Captured on a Remidio Fundus on Phone:
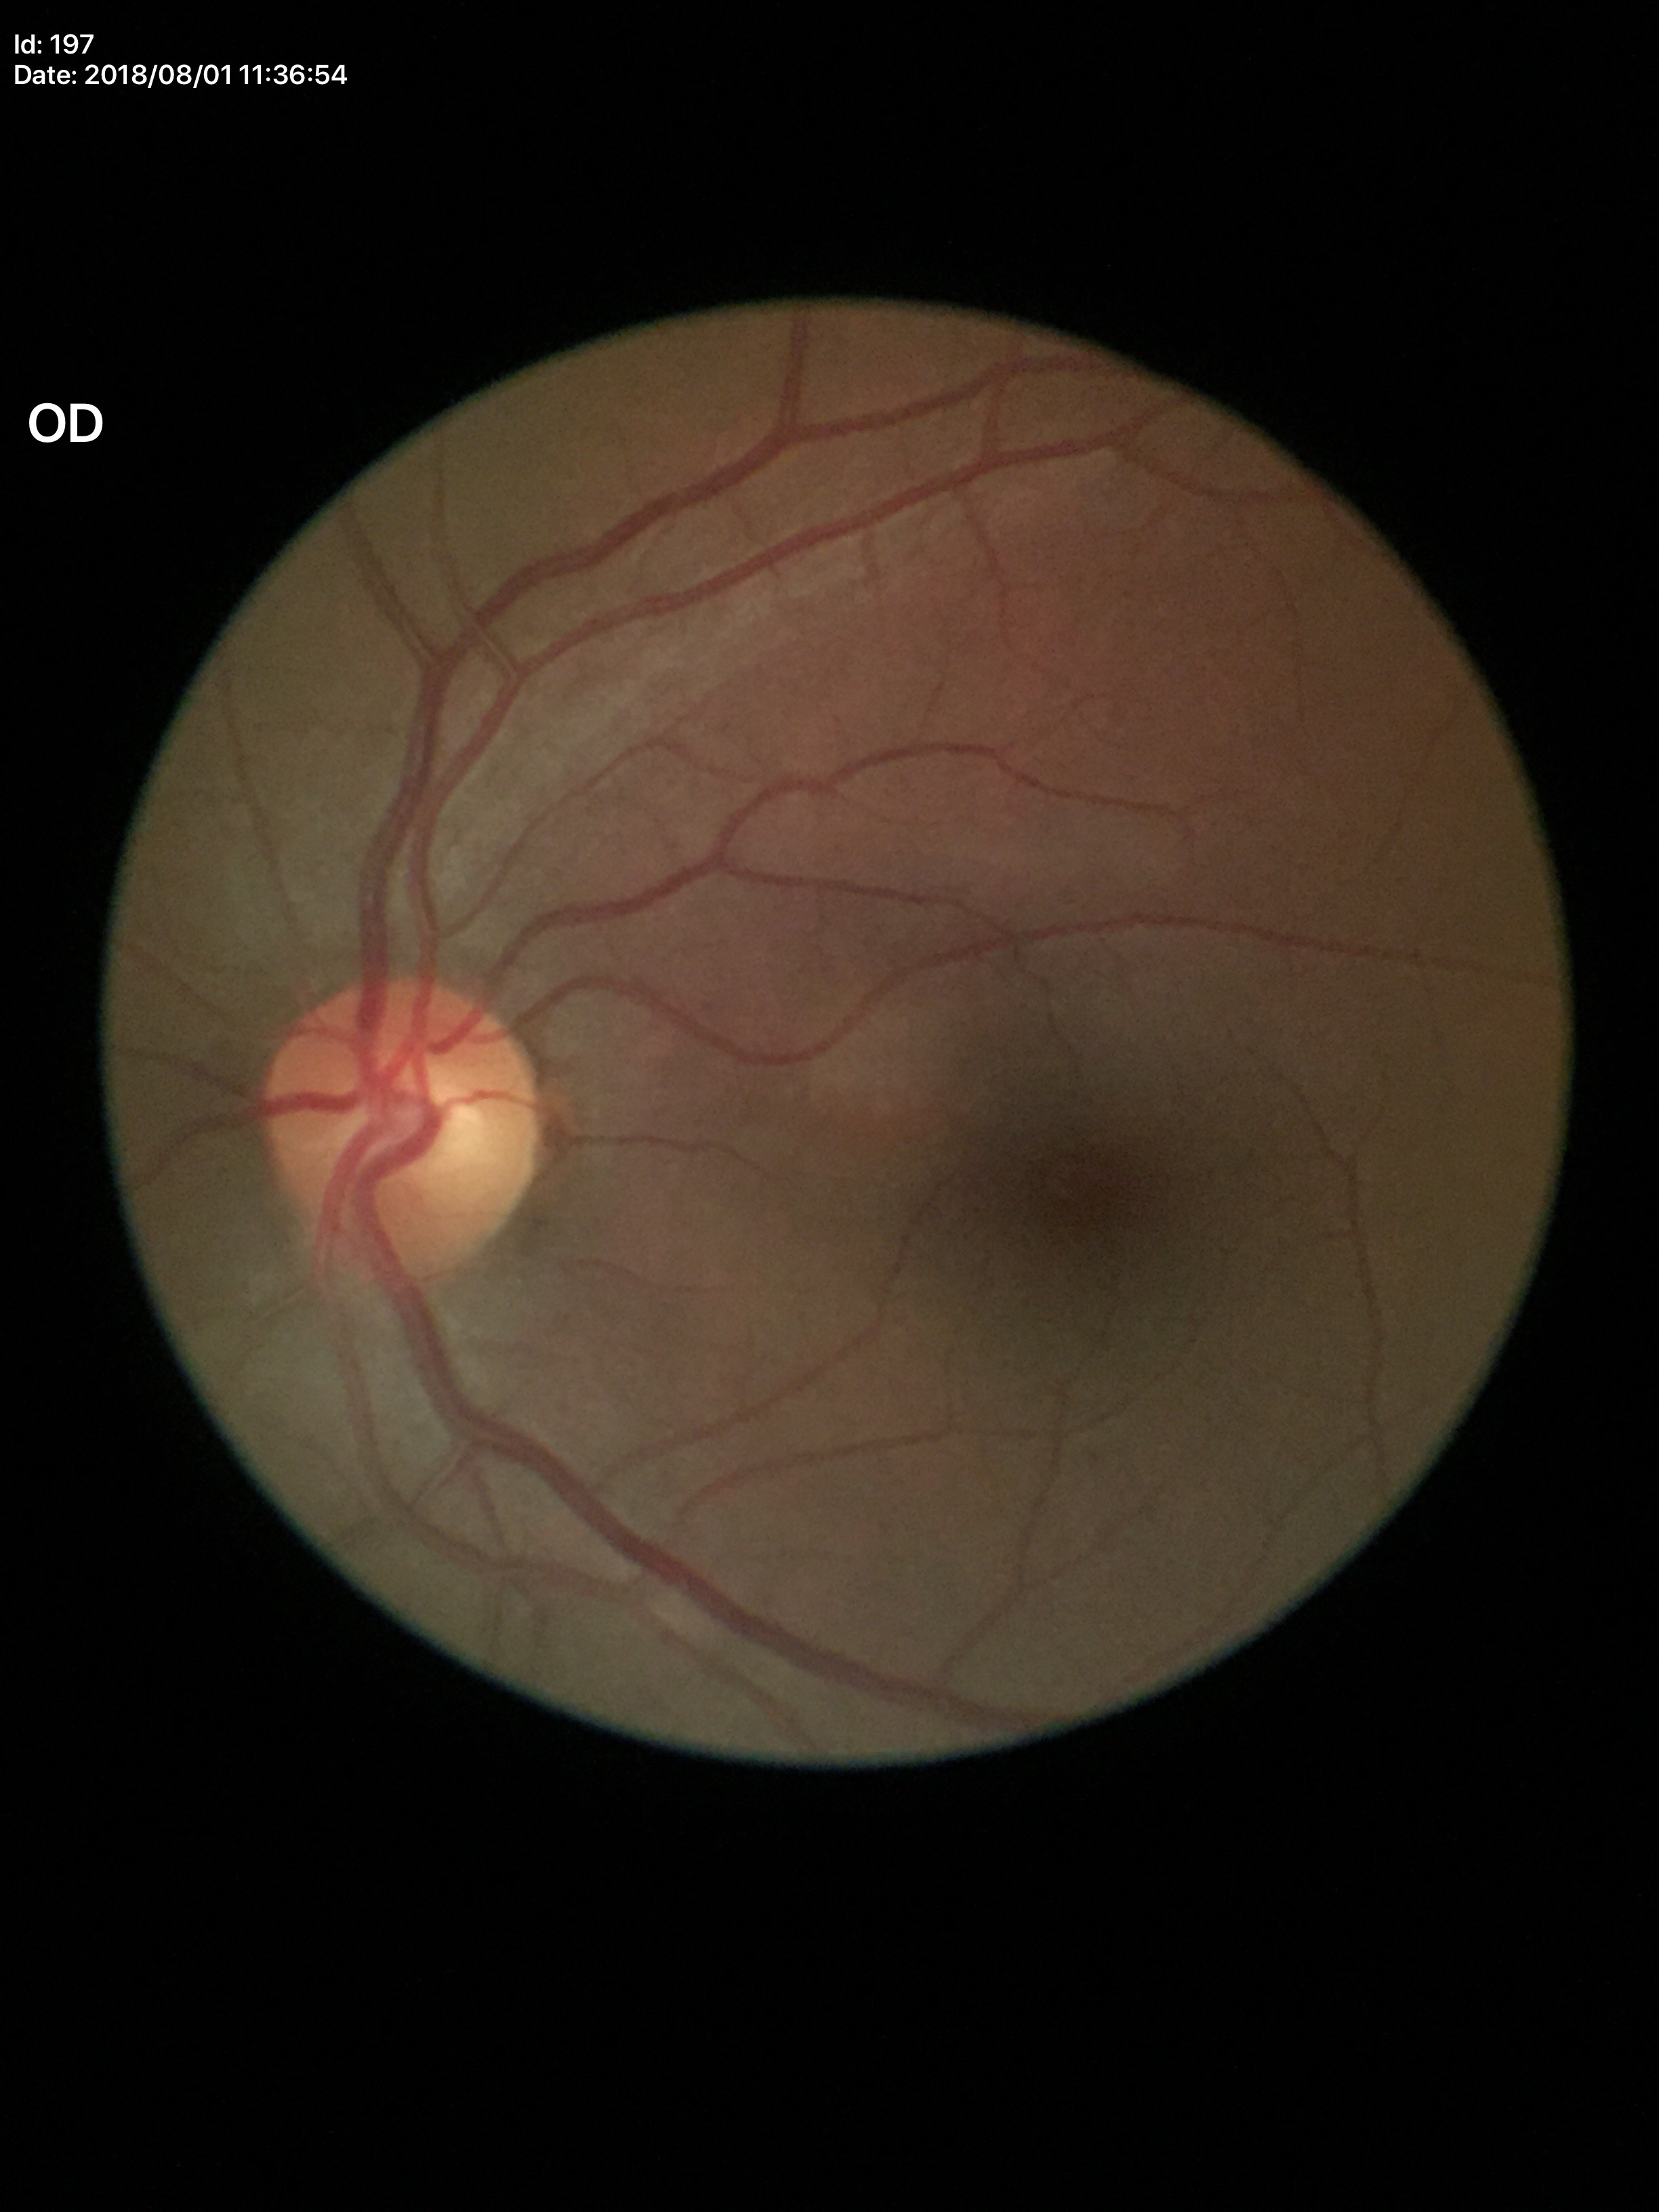 Glaucoma decision: negative. Vertical cup-to-disc ratio (VCDR): 0.50.